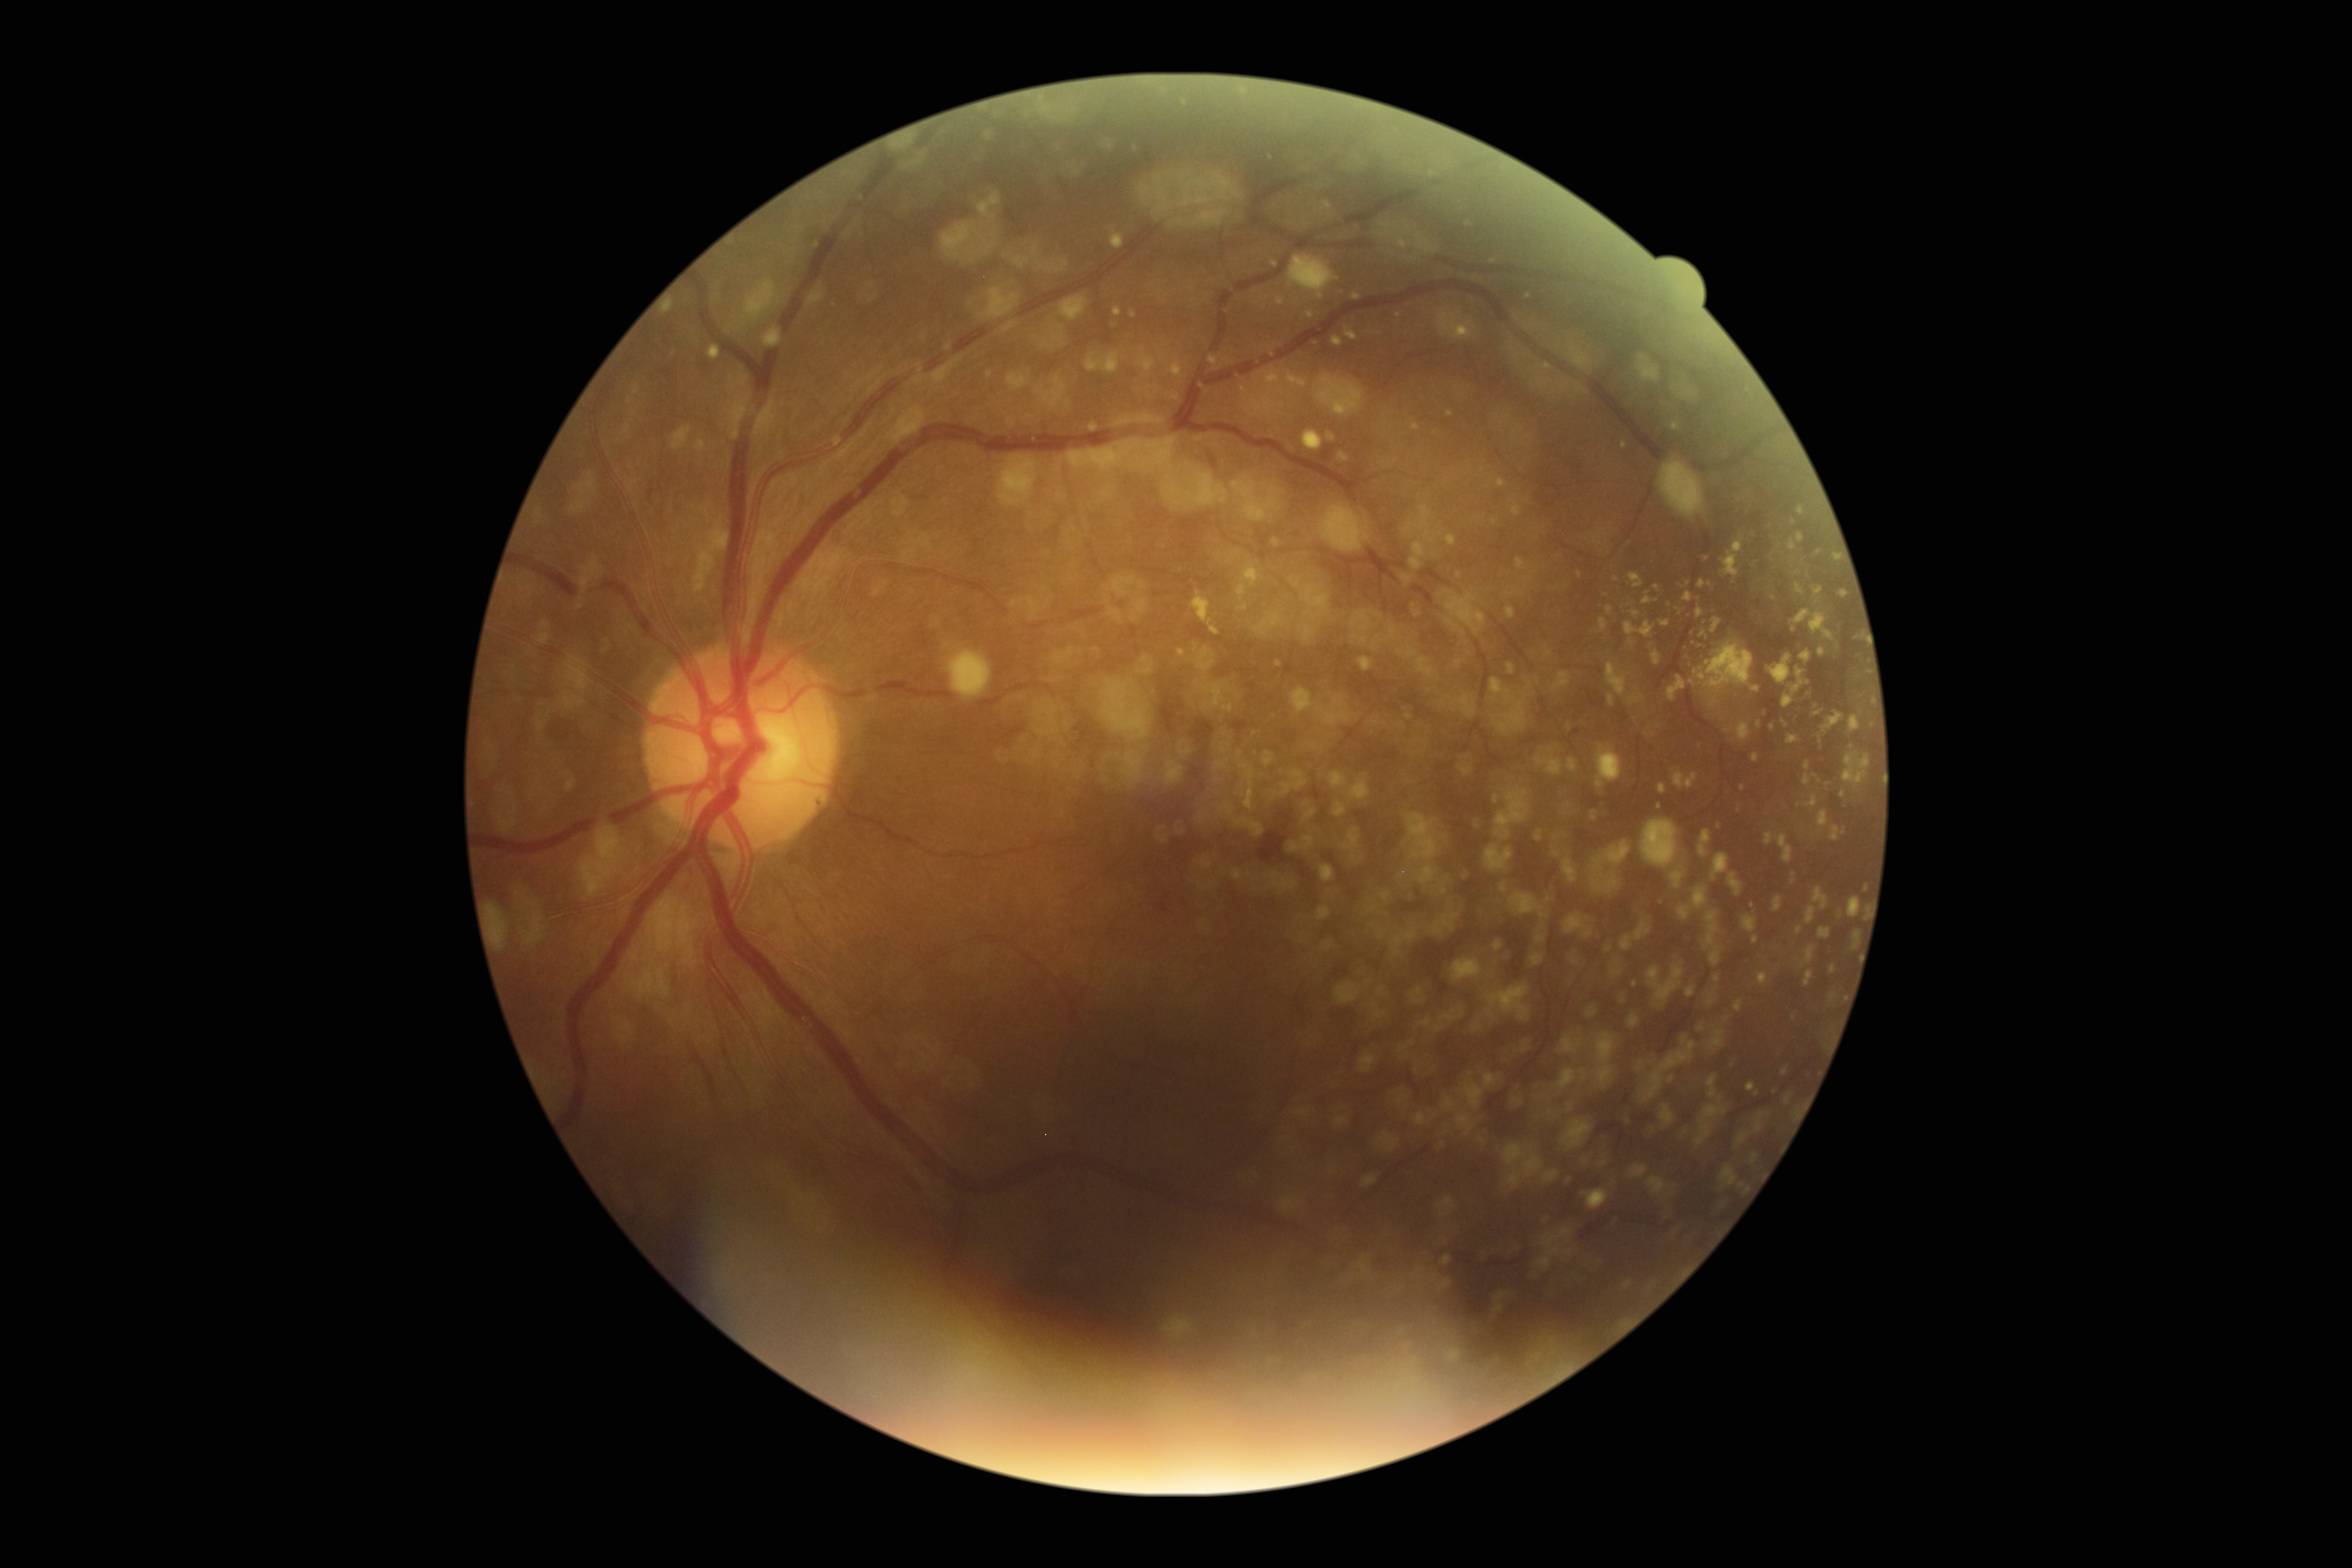

DR = grade 2 (moderate NPDR).